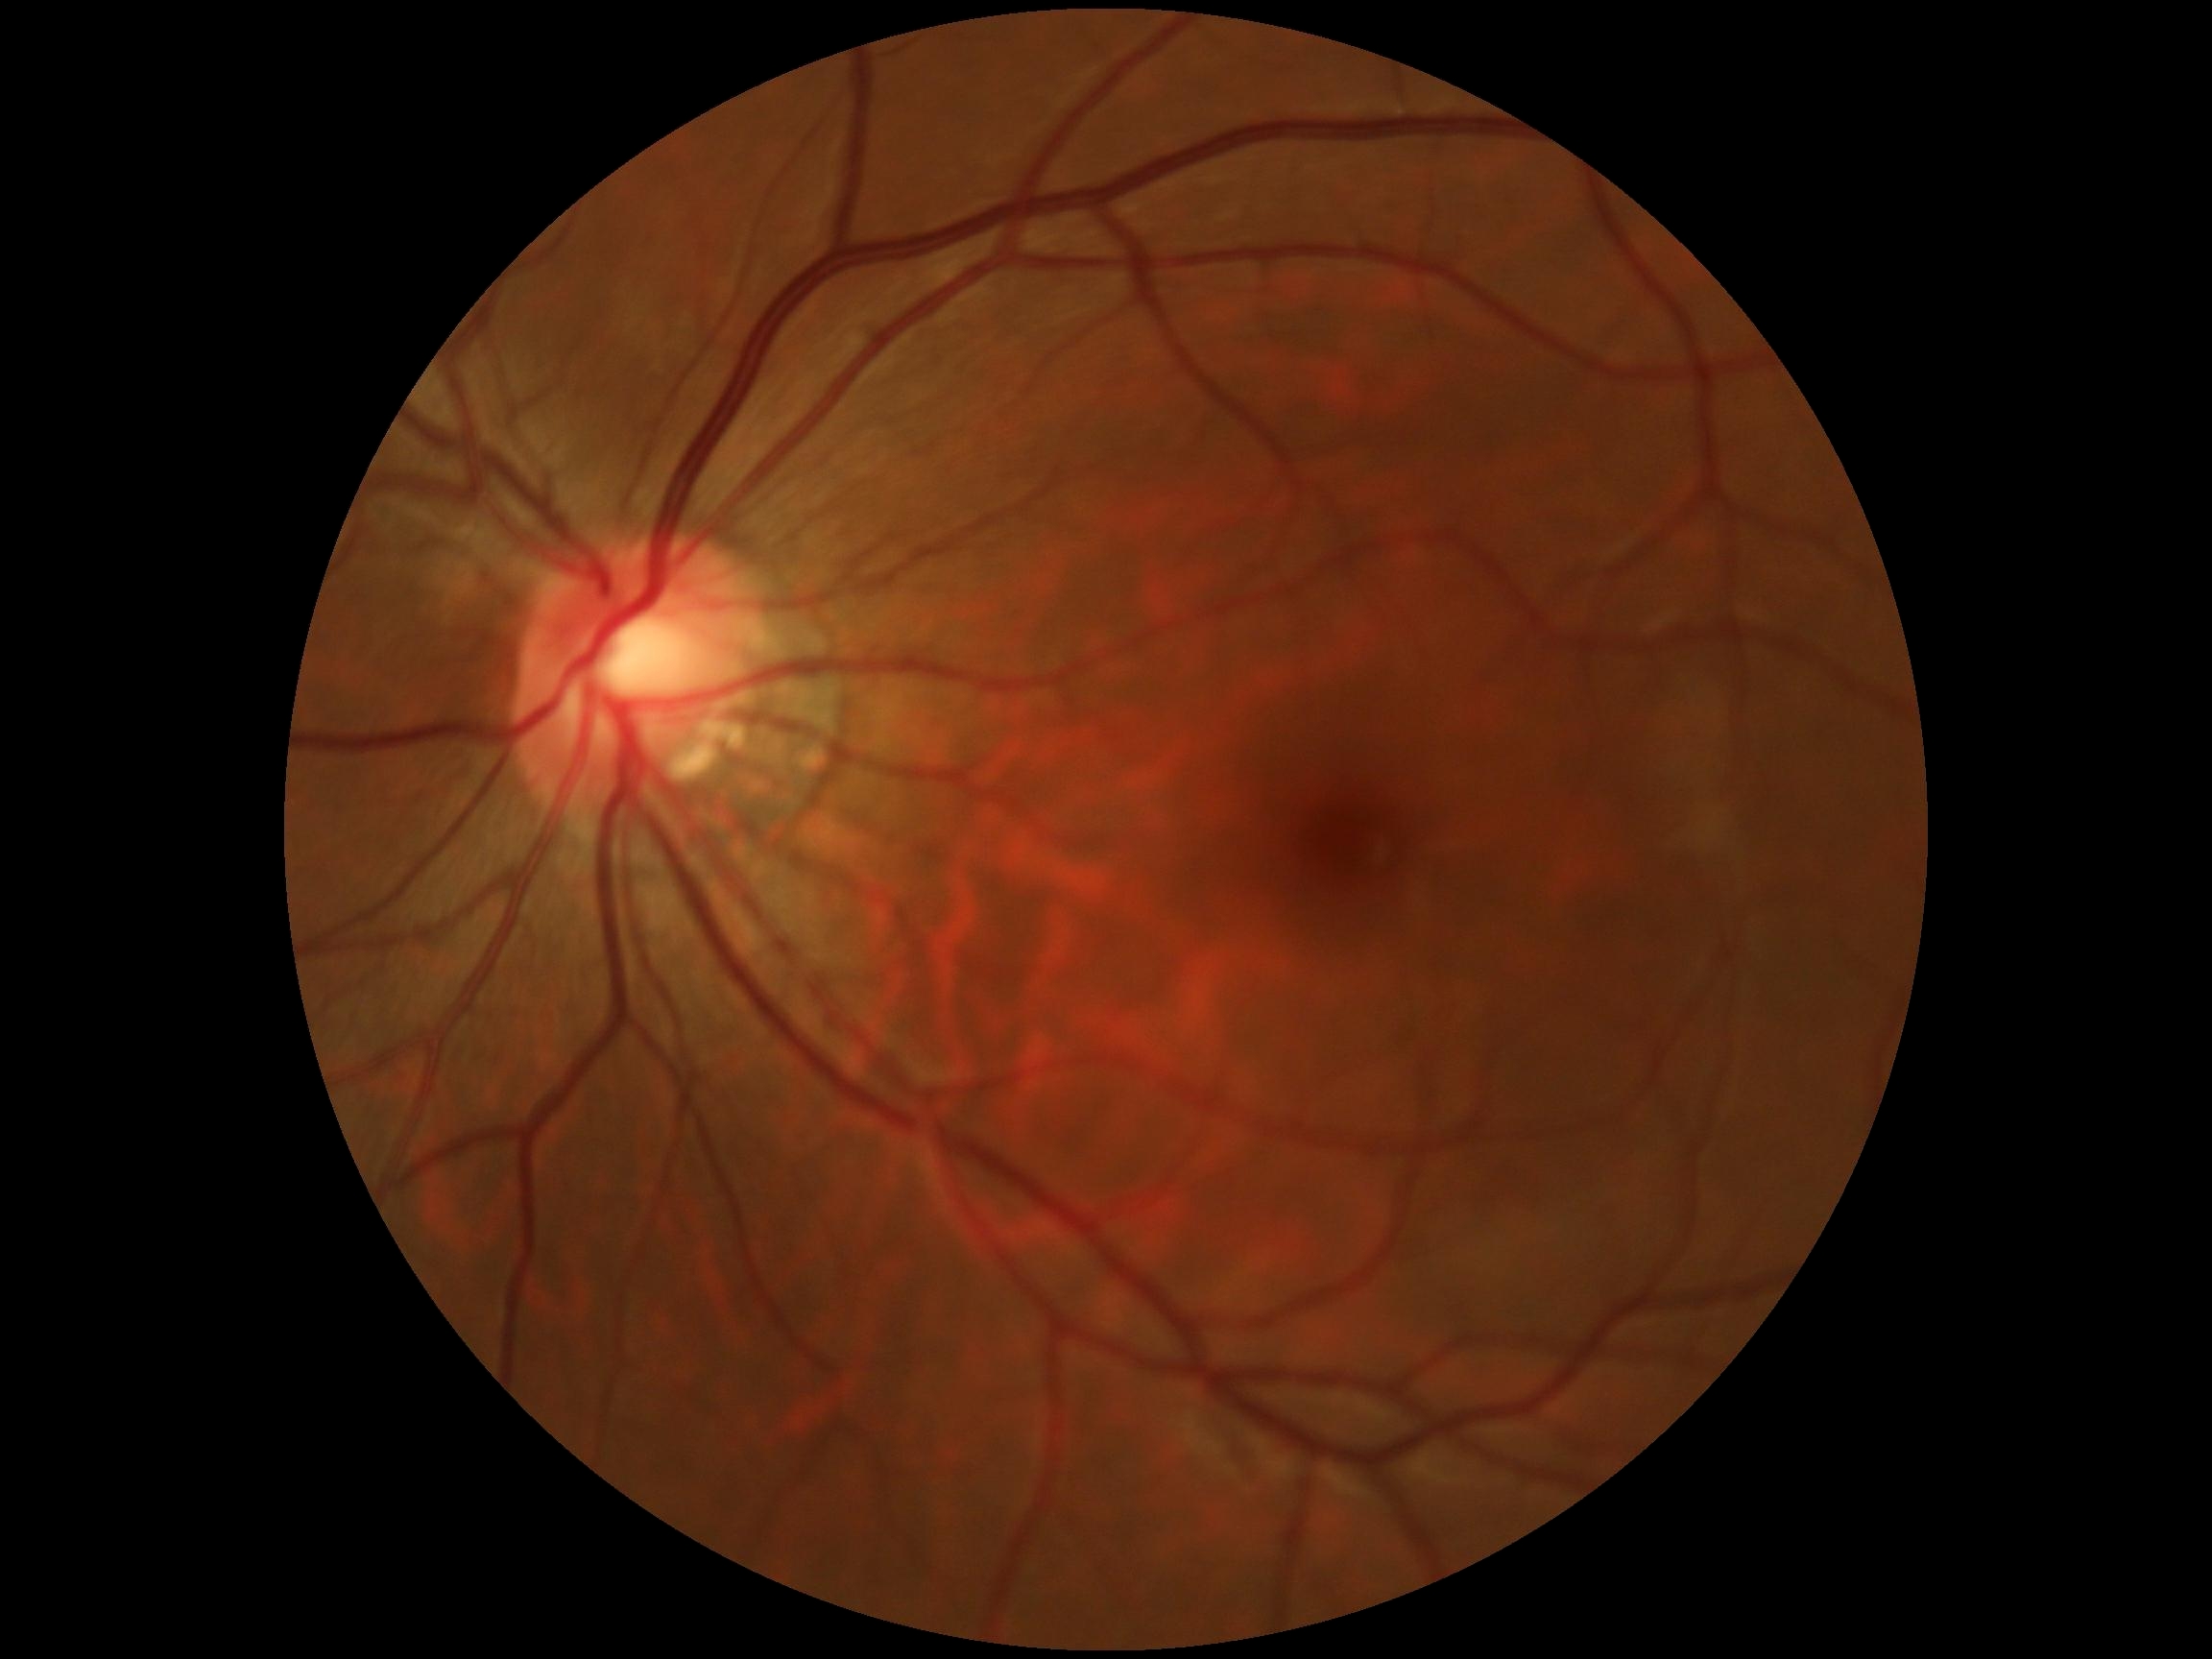
DR severity: grade 0 — no visible signs of diabetic retinopathy.